Wide-field fundus photograph from neonatal ROP screening; acquired on the Clarity RetCam 3
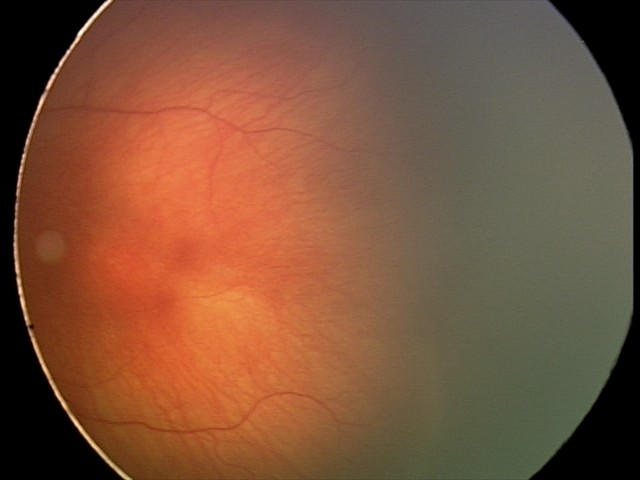 Screening diagnosis = retinopathy of prematurity stage 2.